640x480; acquired on the Clarity RetCam 3; pediatric wide-field fundus photograph — 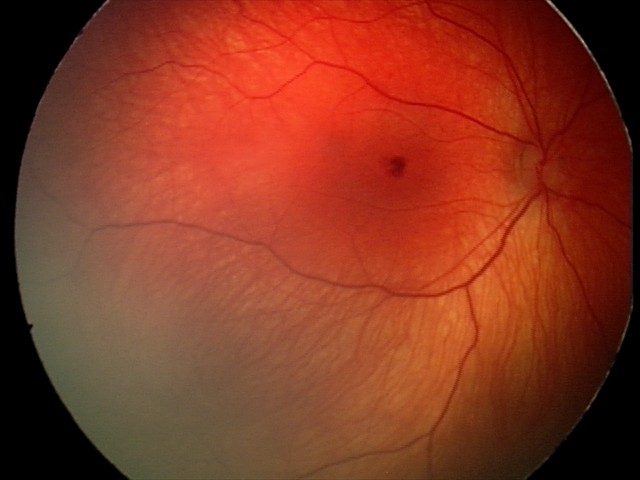
Screening examination consistent with retinal hemorrhages.